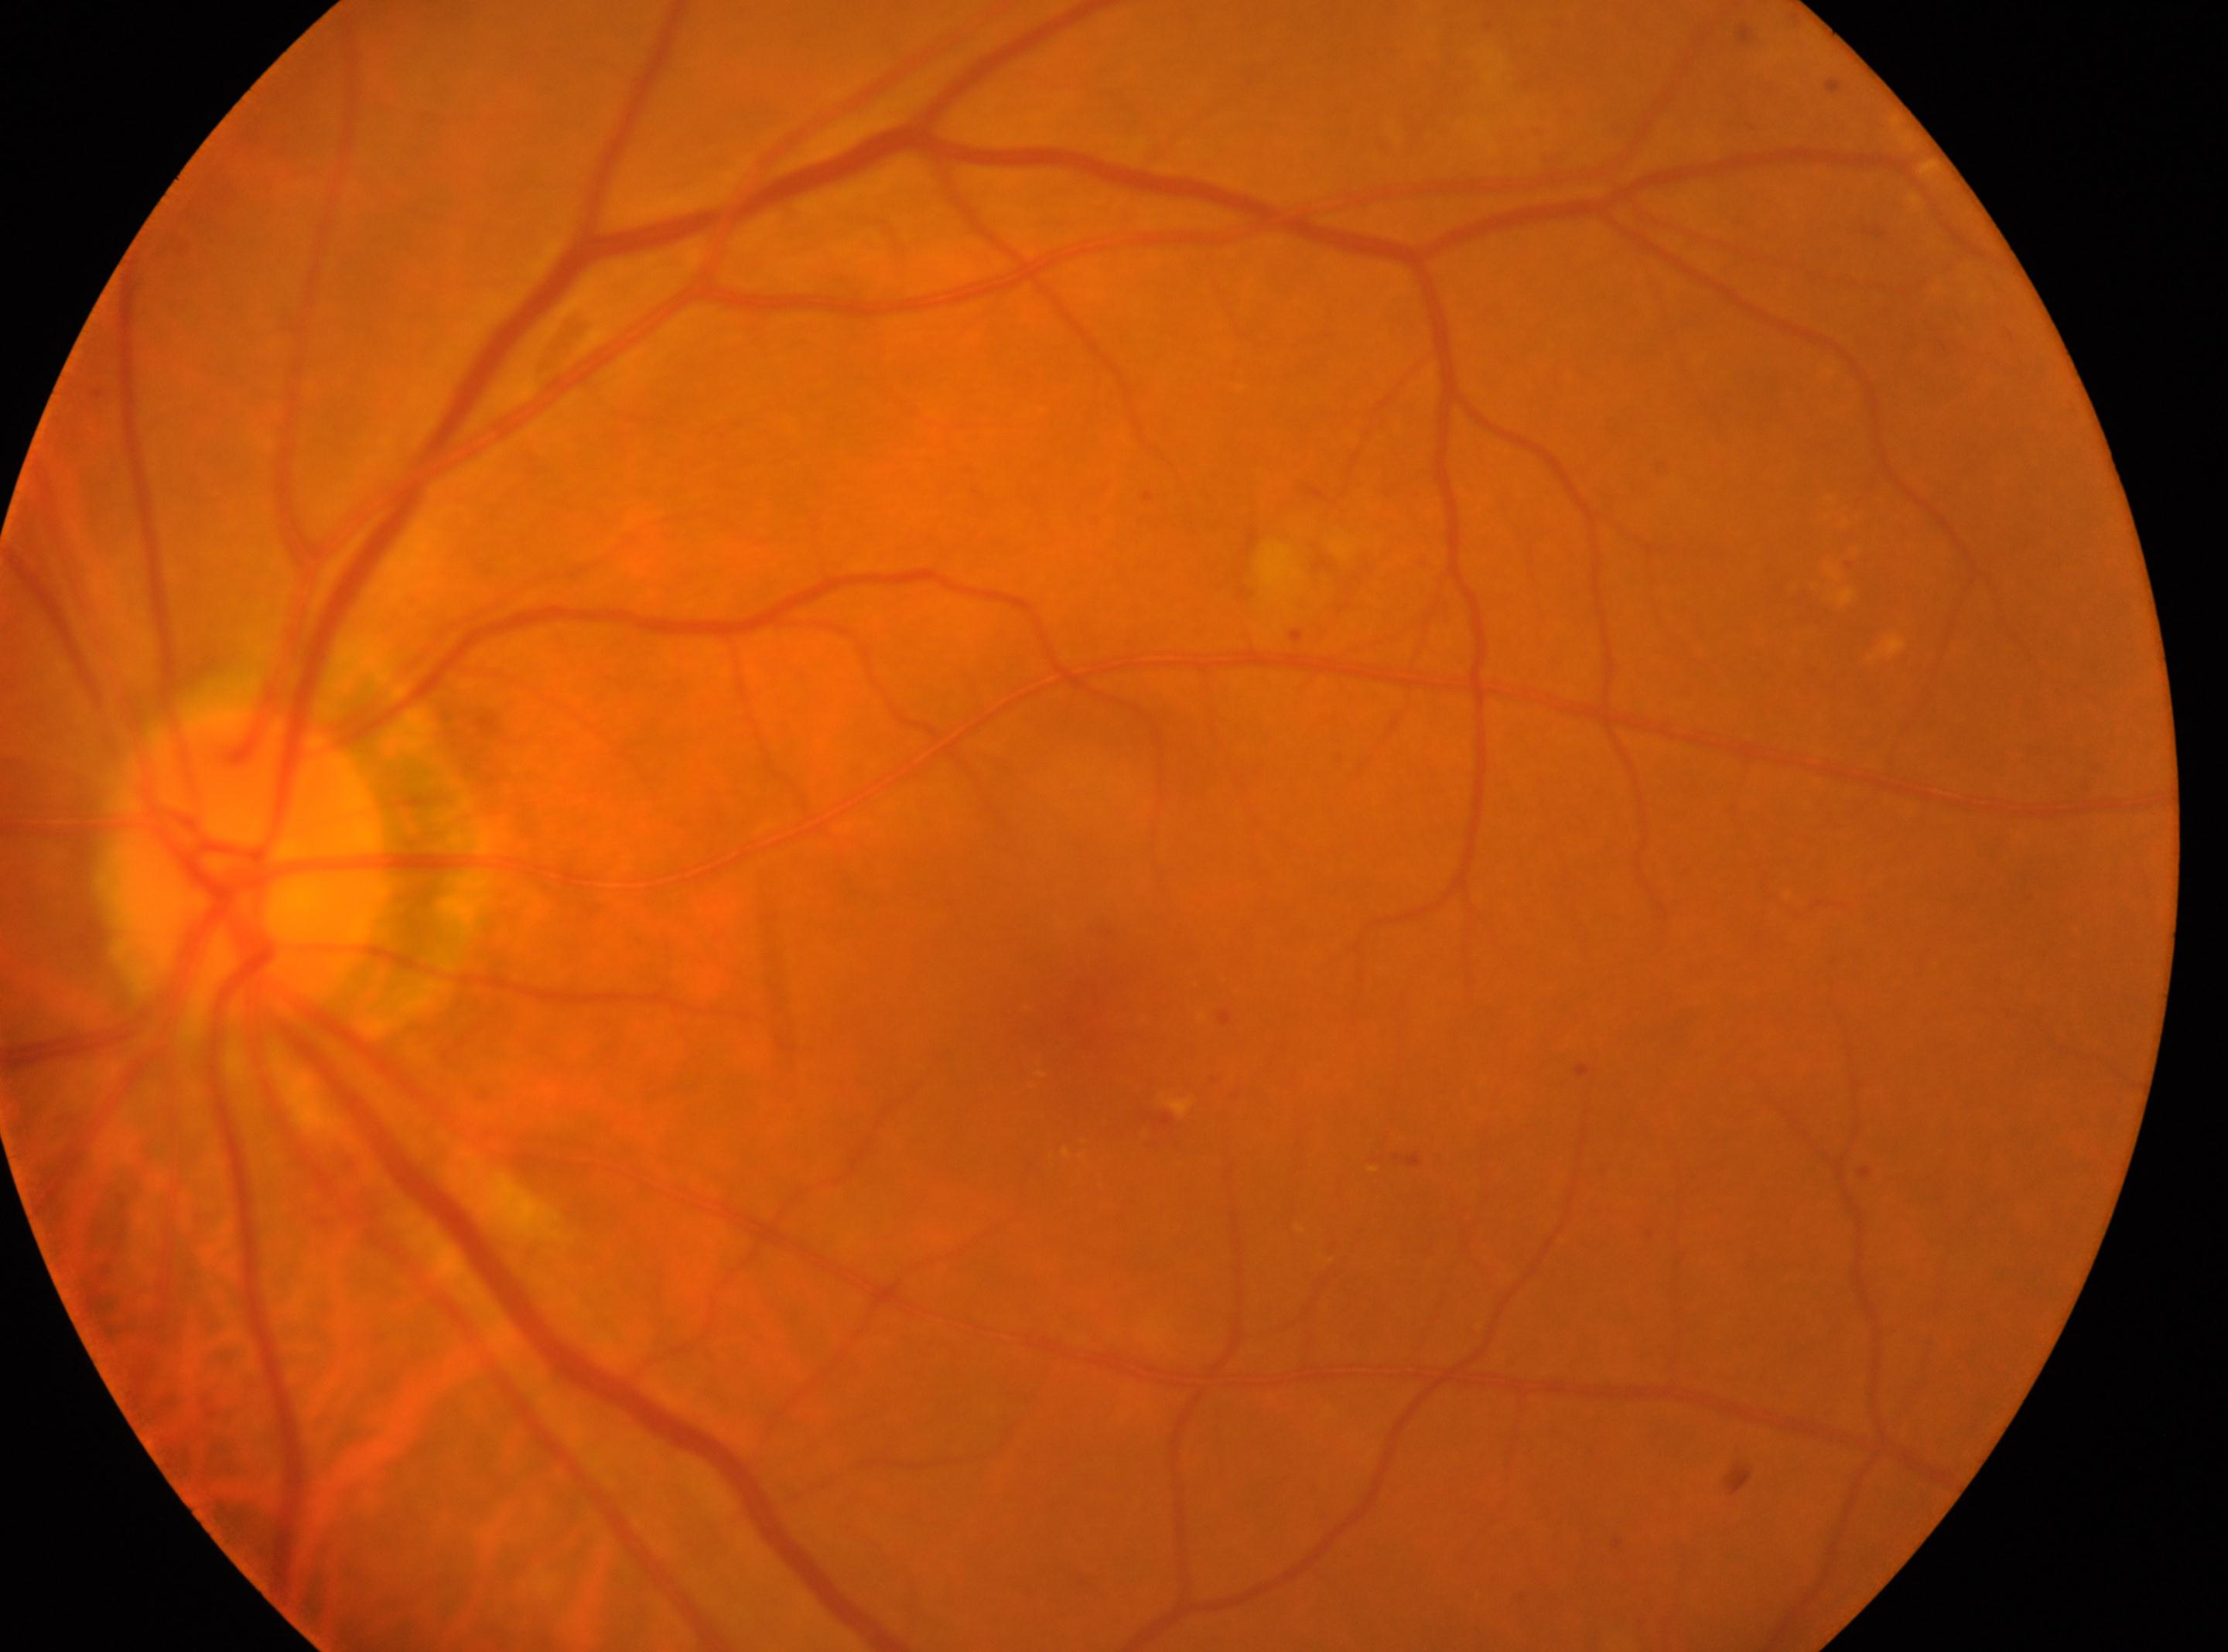 This is the oculus sinister.
The fovea centralis is at (1106,1036).
The optic disk is at (248,862).
Retinopathy grade: 2 (moderate NPDR).